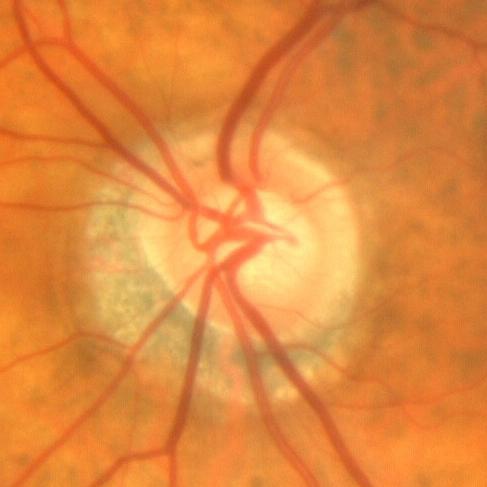 Optic nerve head photograph demonstrating no glaucomatous findings.